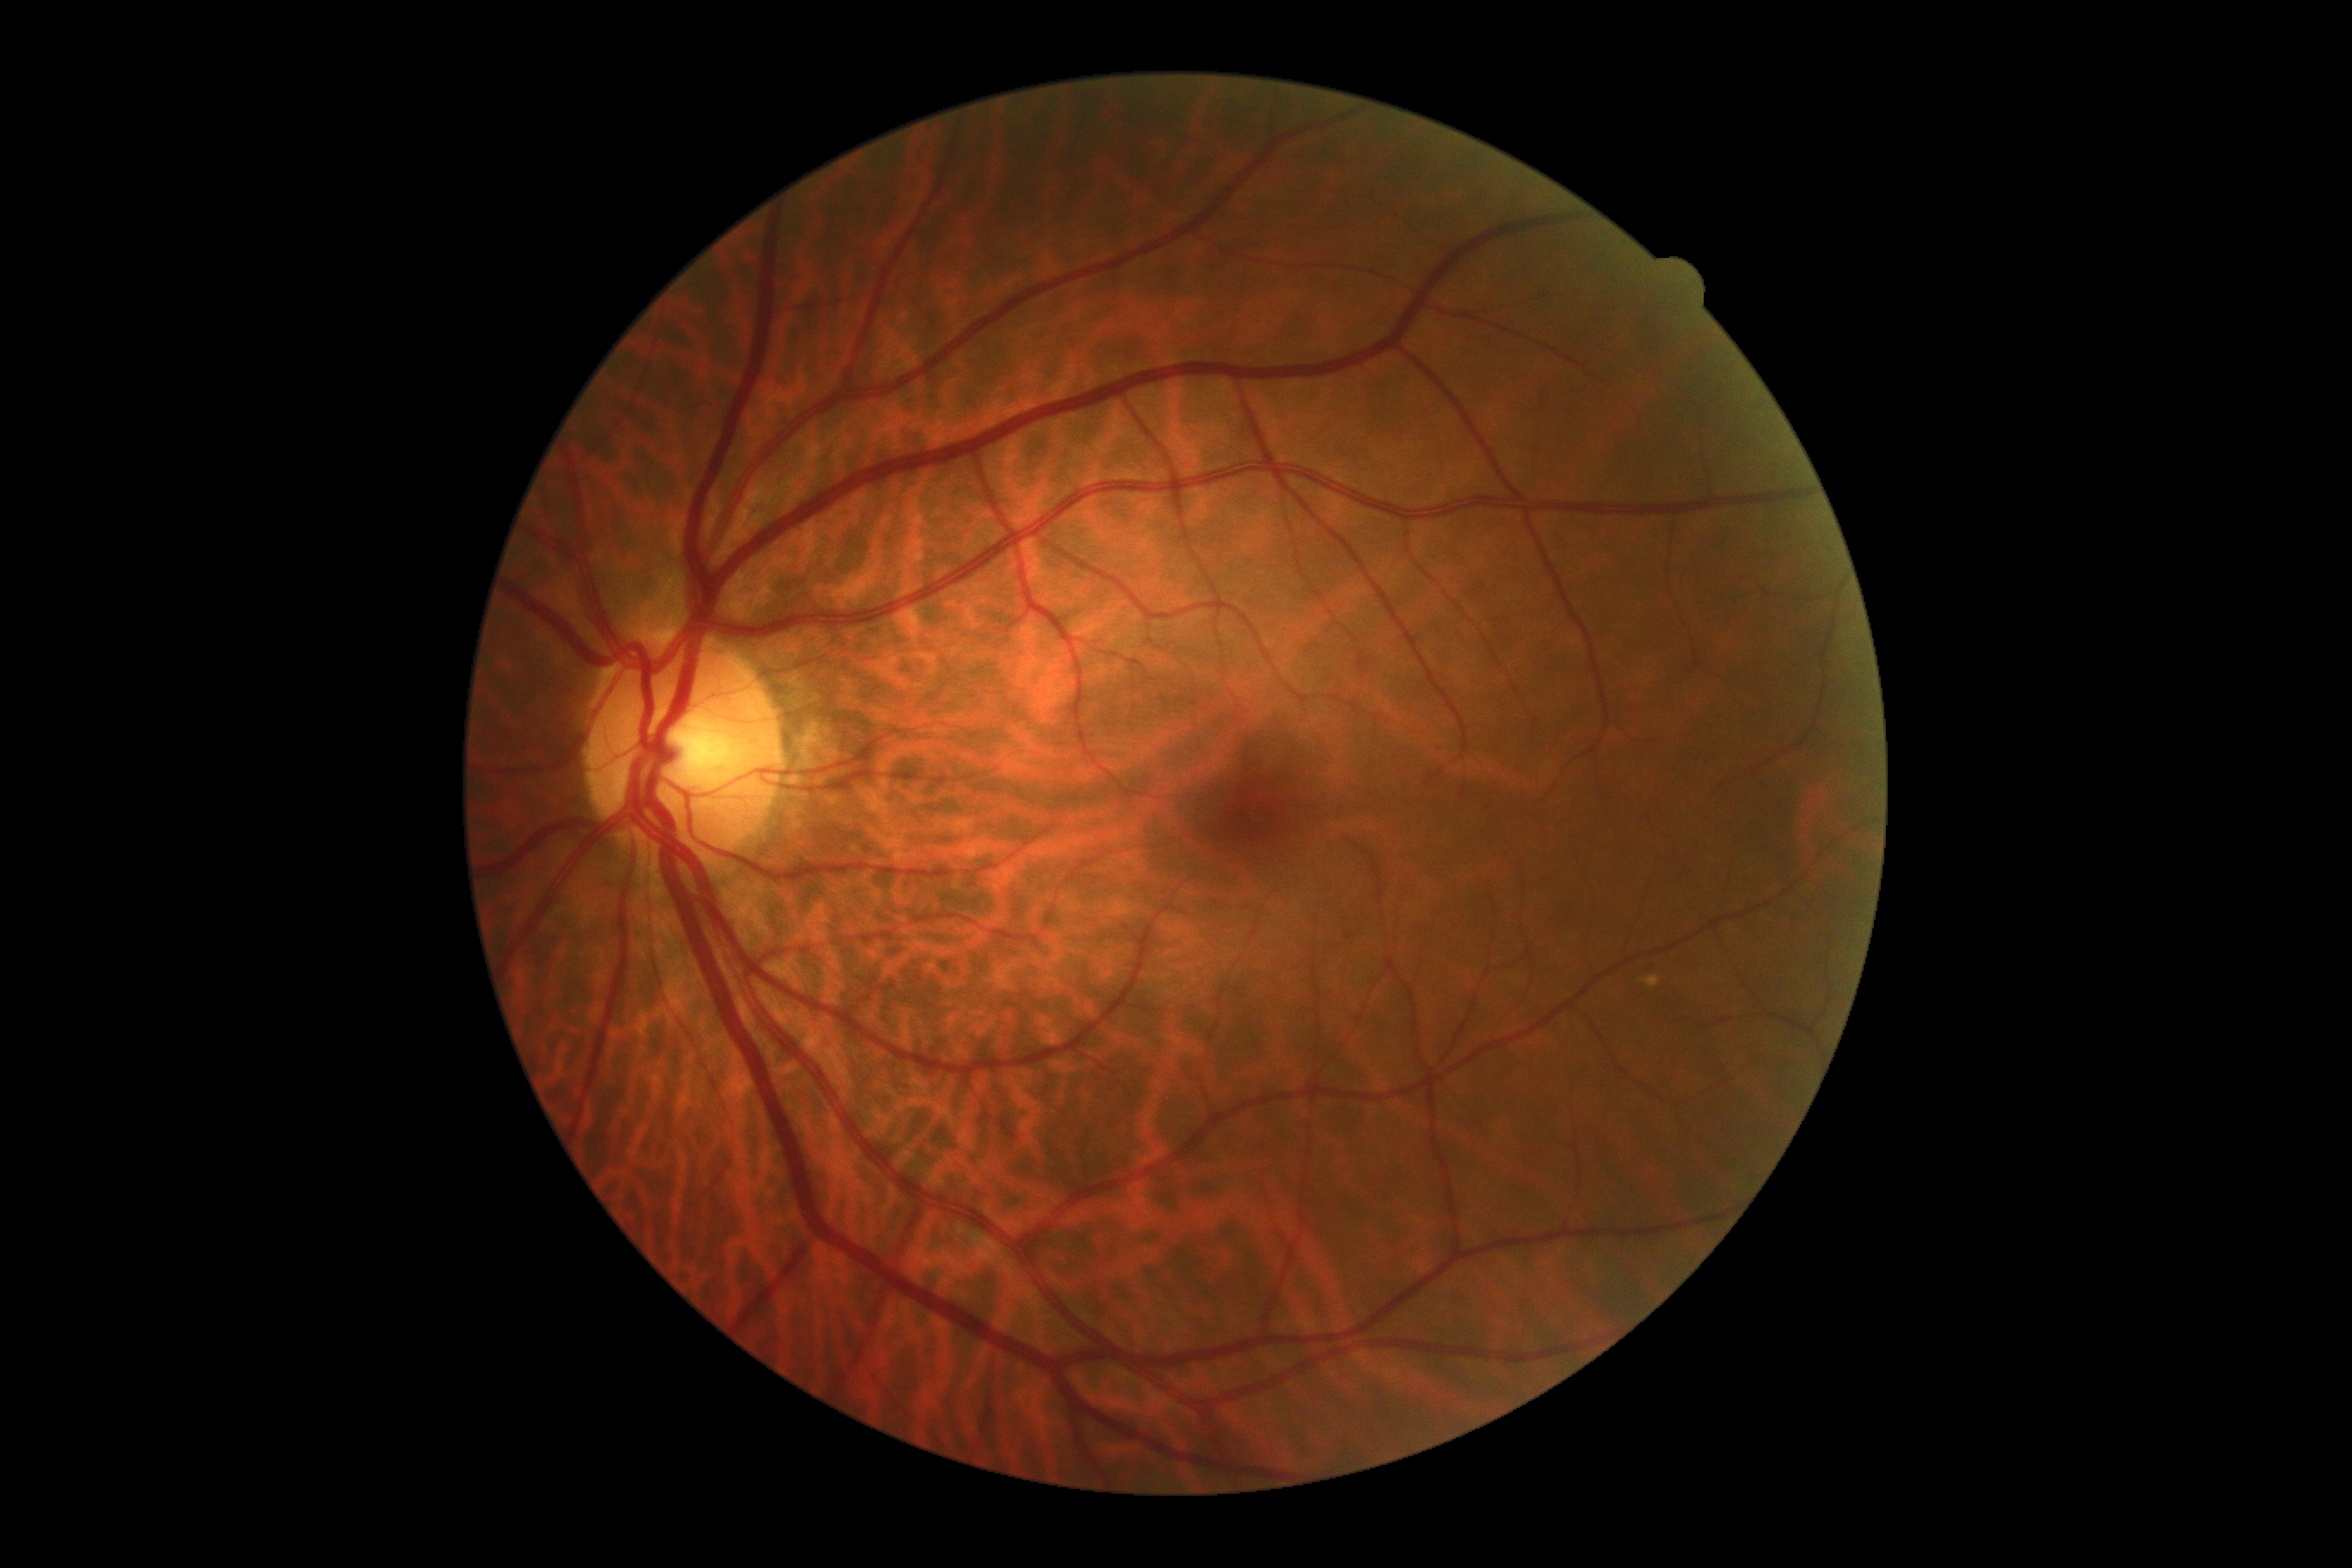

retinopathy = no apparent retinopathy (grade 0), DR impression = negative for DR.